240x240: 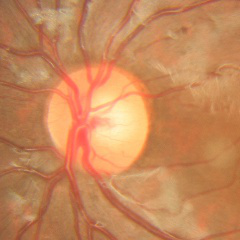
Q: Glaucoma assessment?
A: No signs of glaucoma.